Wide-field fundus photograph of an infant; 130° field of view (Natus RetCam Envision):
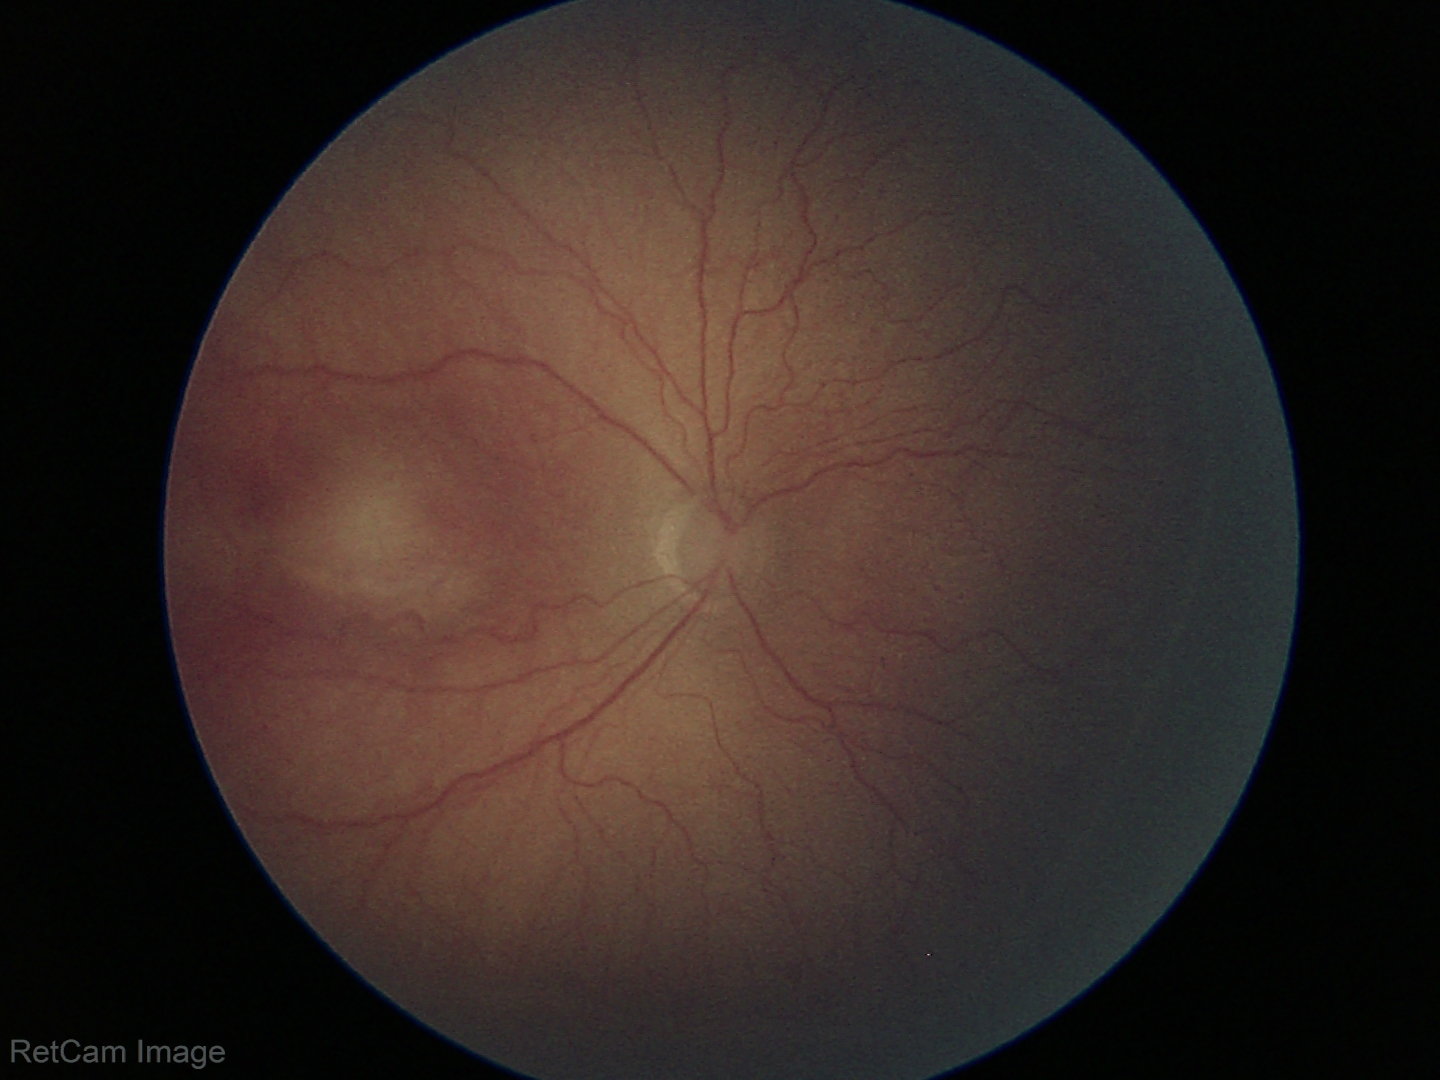
Impression: no plus disease | retinopathy of prematurity stage 2.